Diabetic retinopathy graded by the modified Davis classification
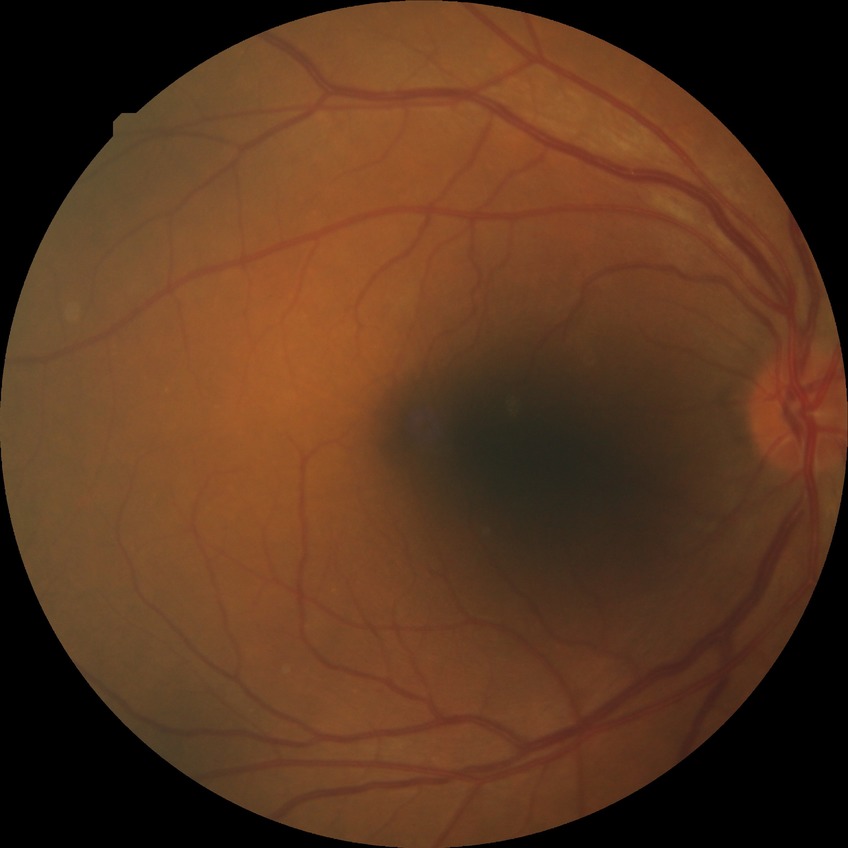
Diabetic retinopathy (DR) is NDR (no diabetic retinopathy).